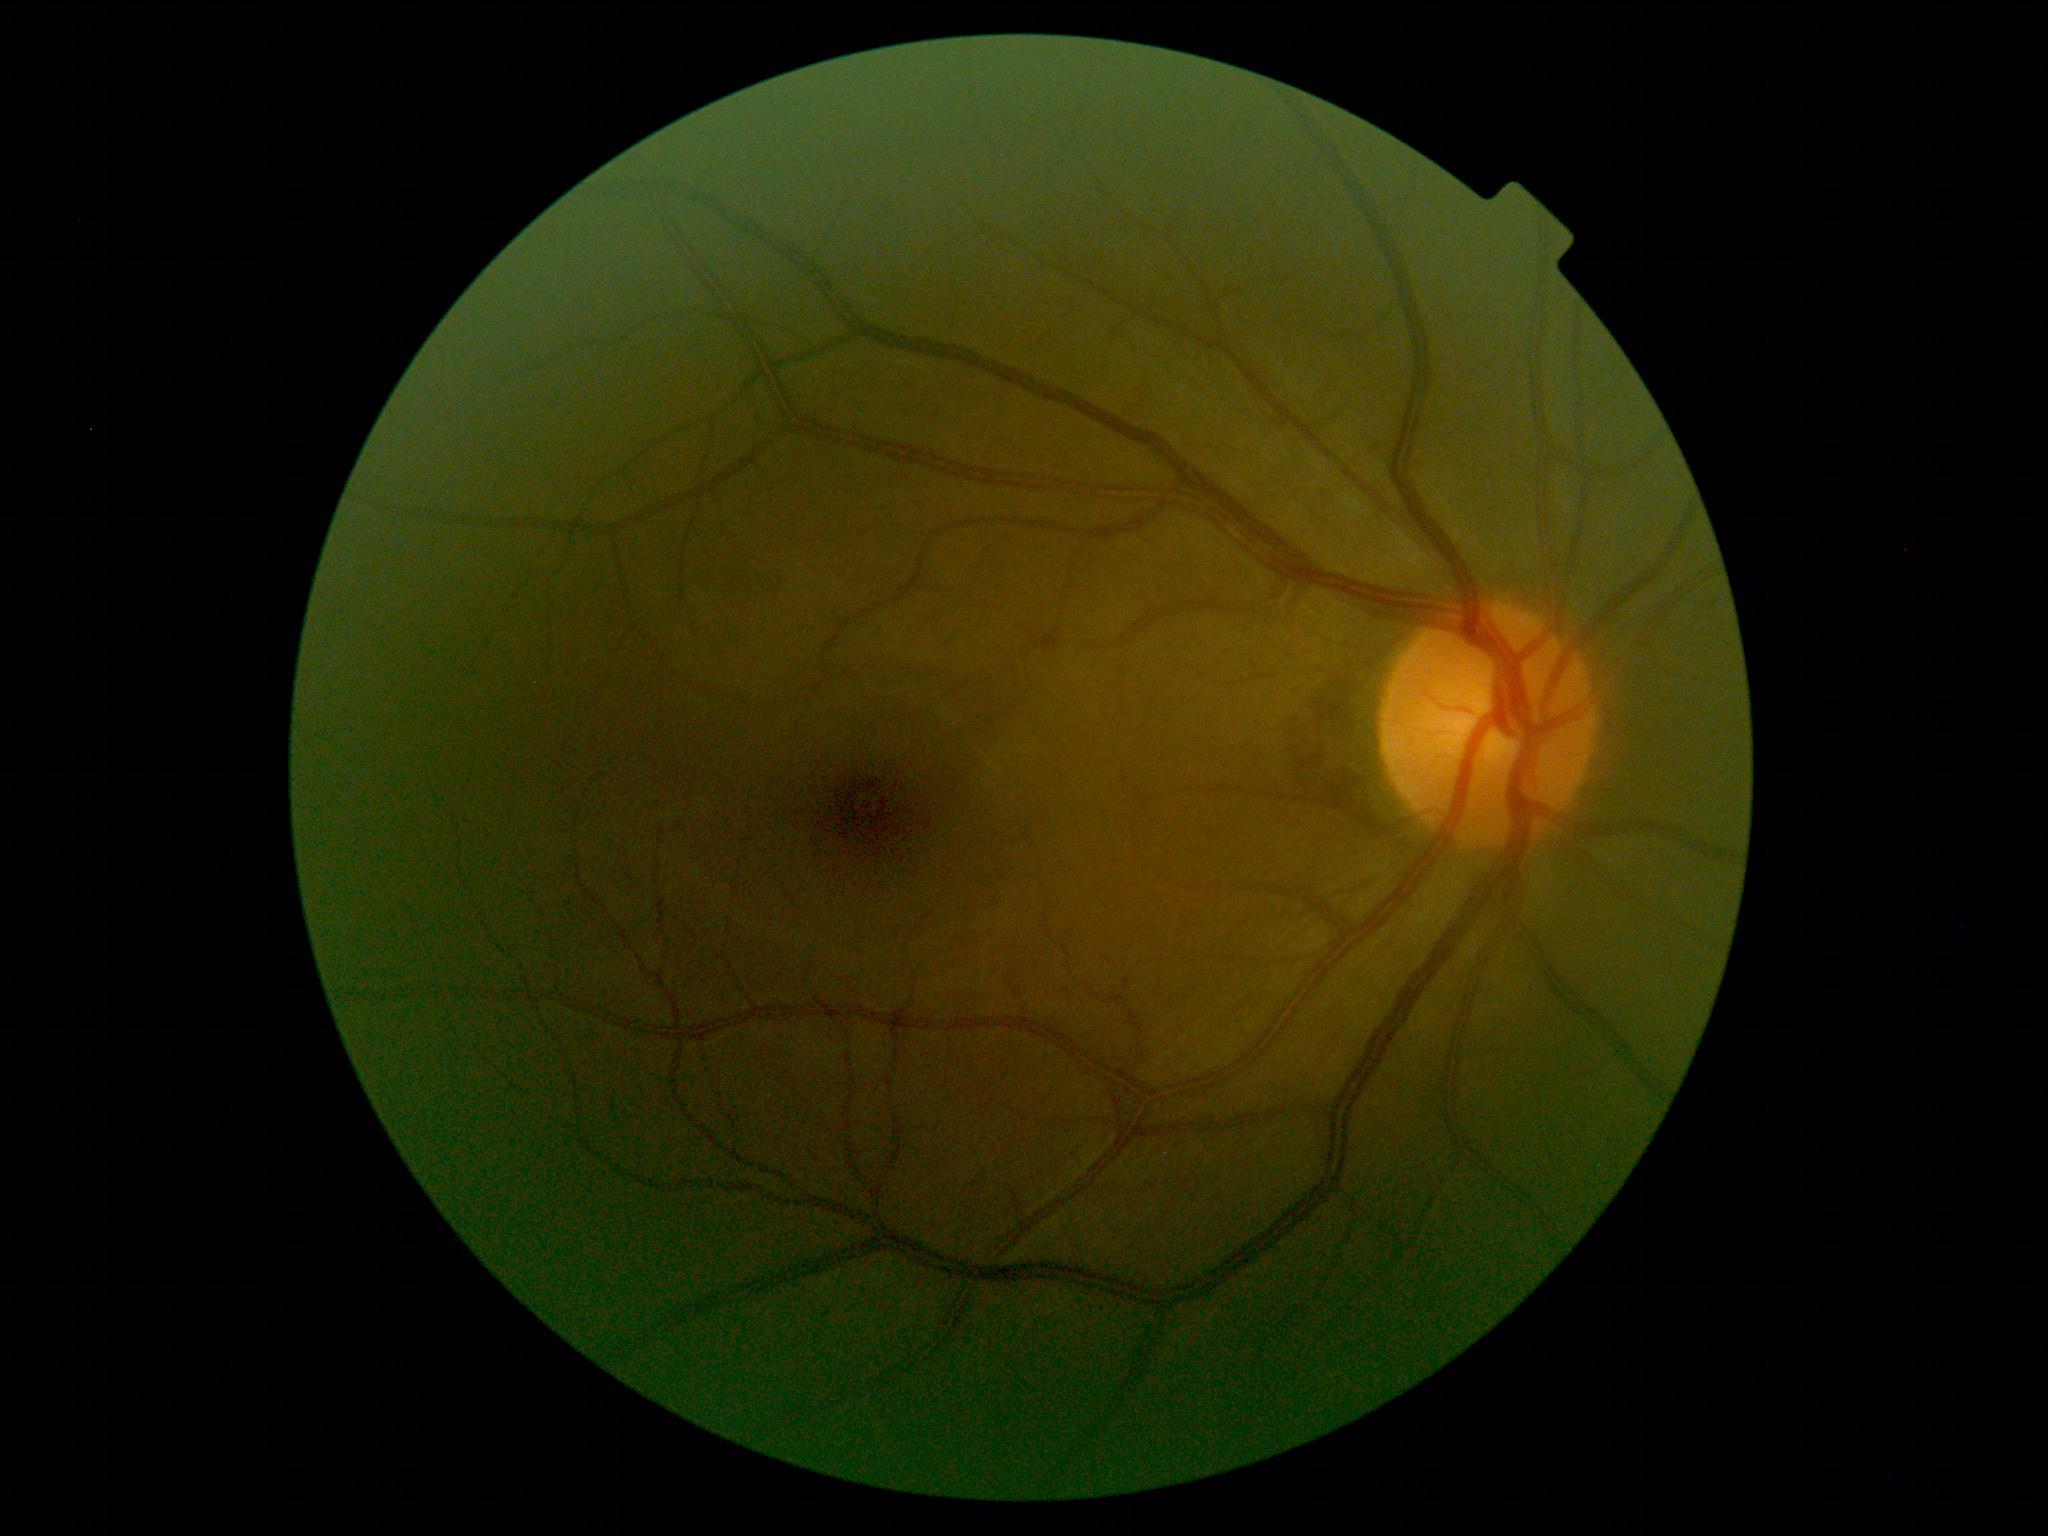 Diabetic retinopathy (DR): 0/4.